Color fundus image.
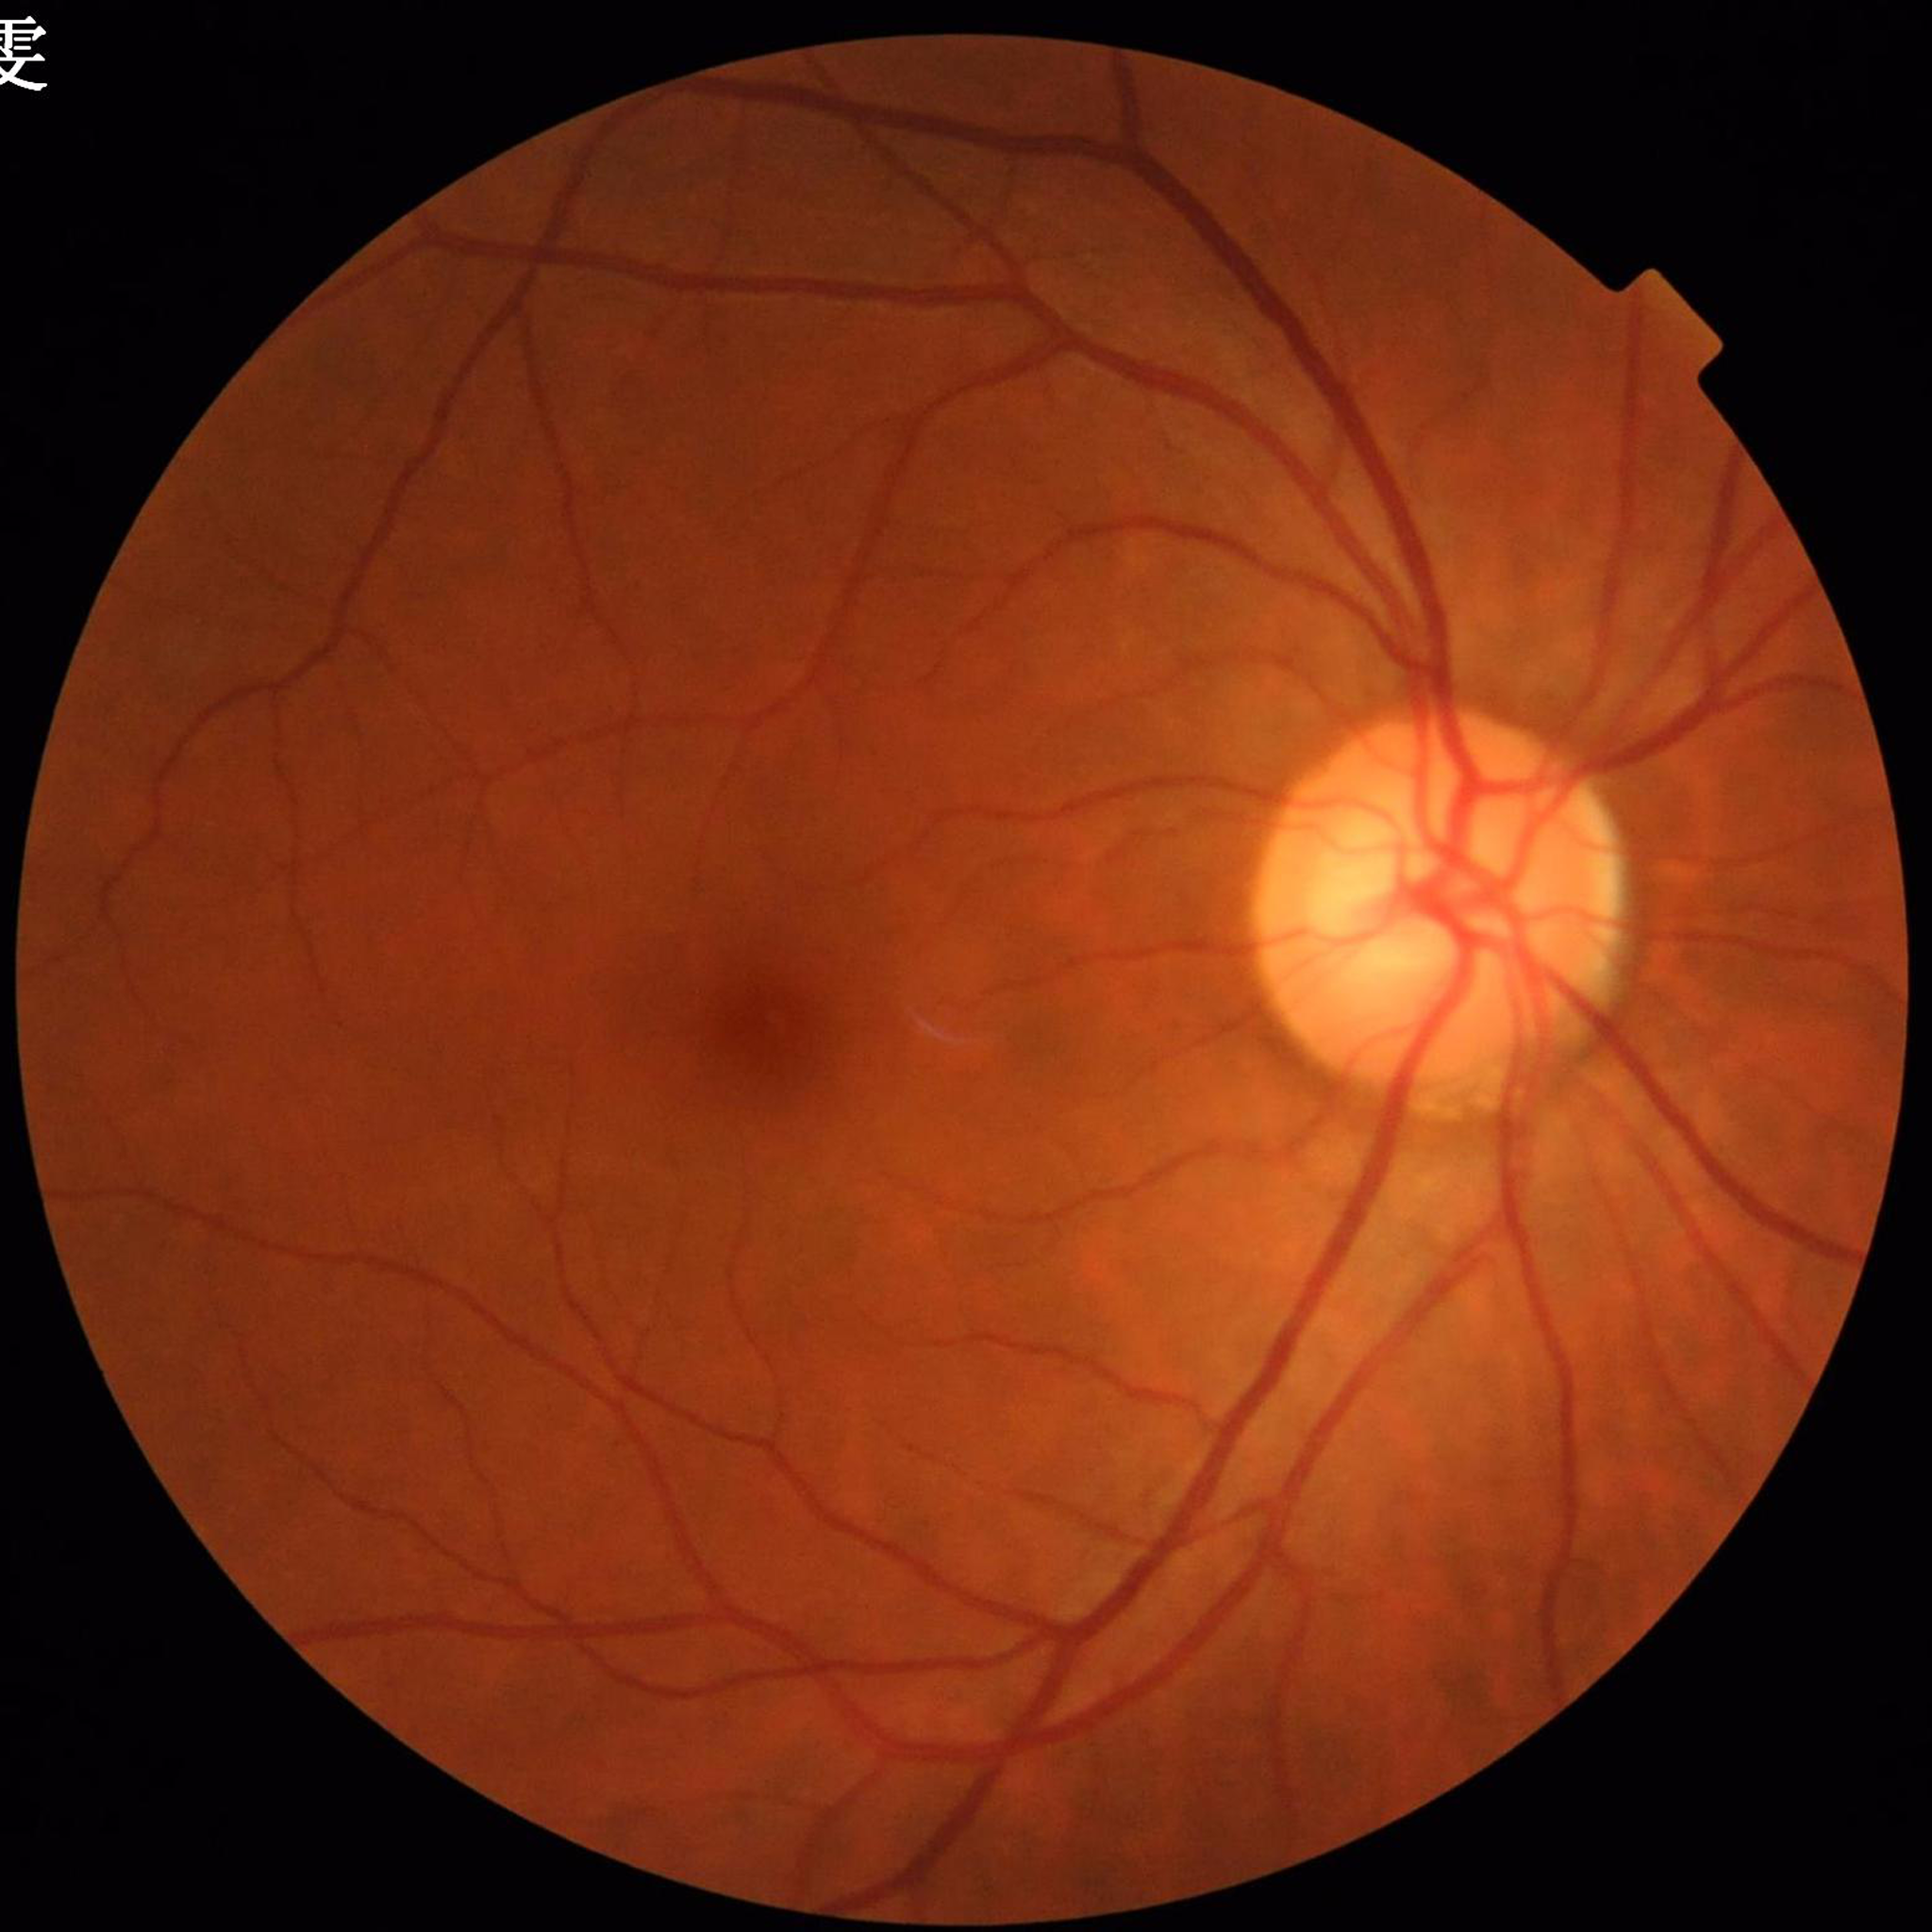

diagnosis: glaucoma